Wide-field fundus photograph of an infant:
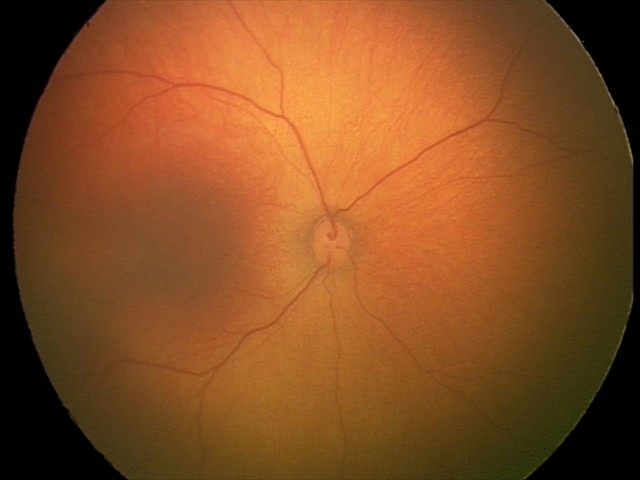 Physiological retinal appearance for postconceptual age.